2048 by 1536 pixels · fundus photo — 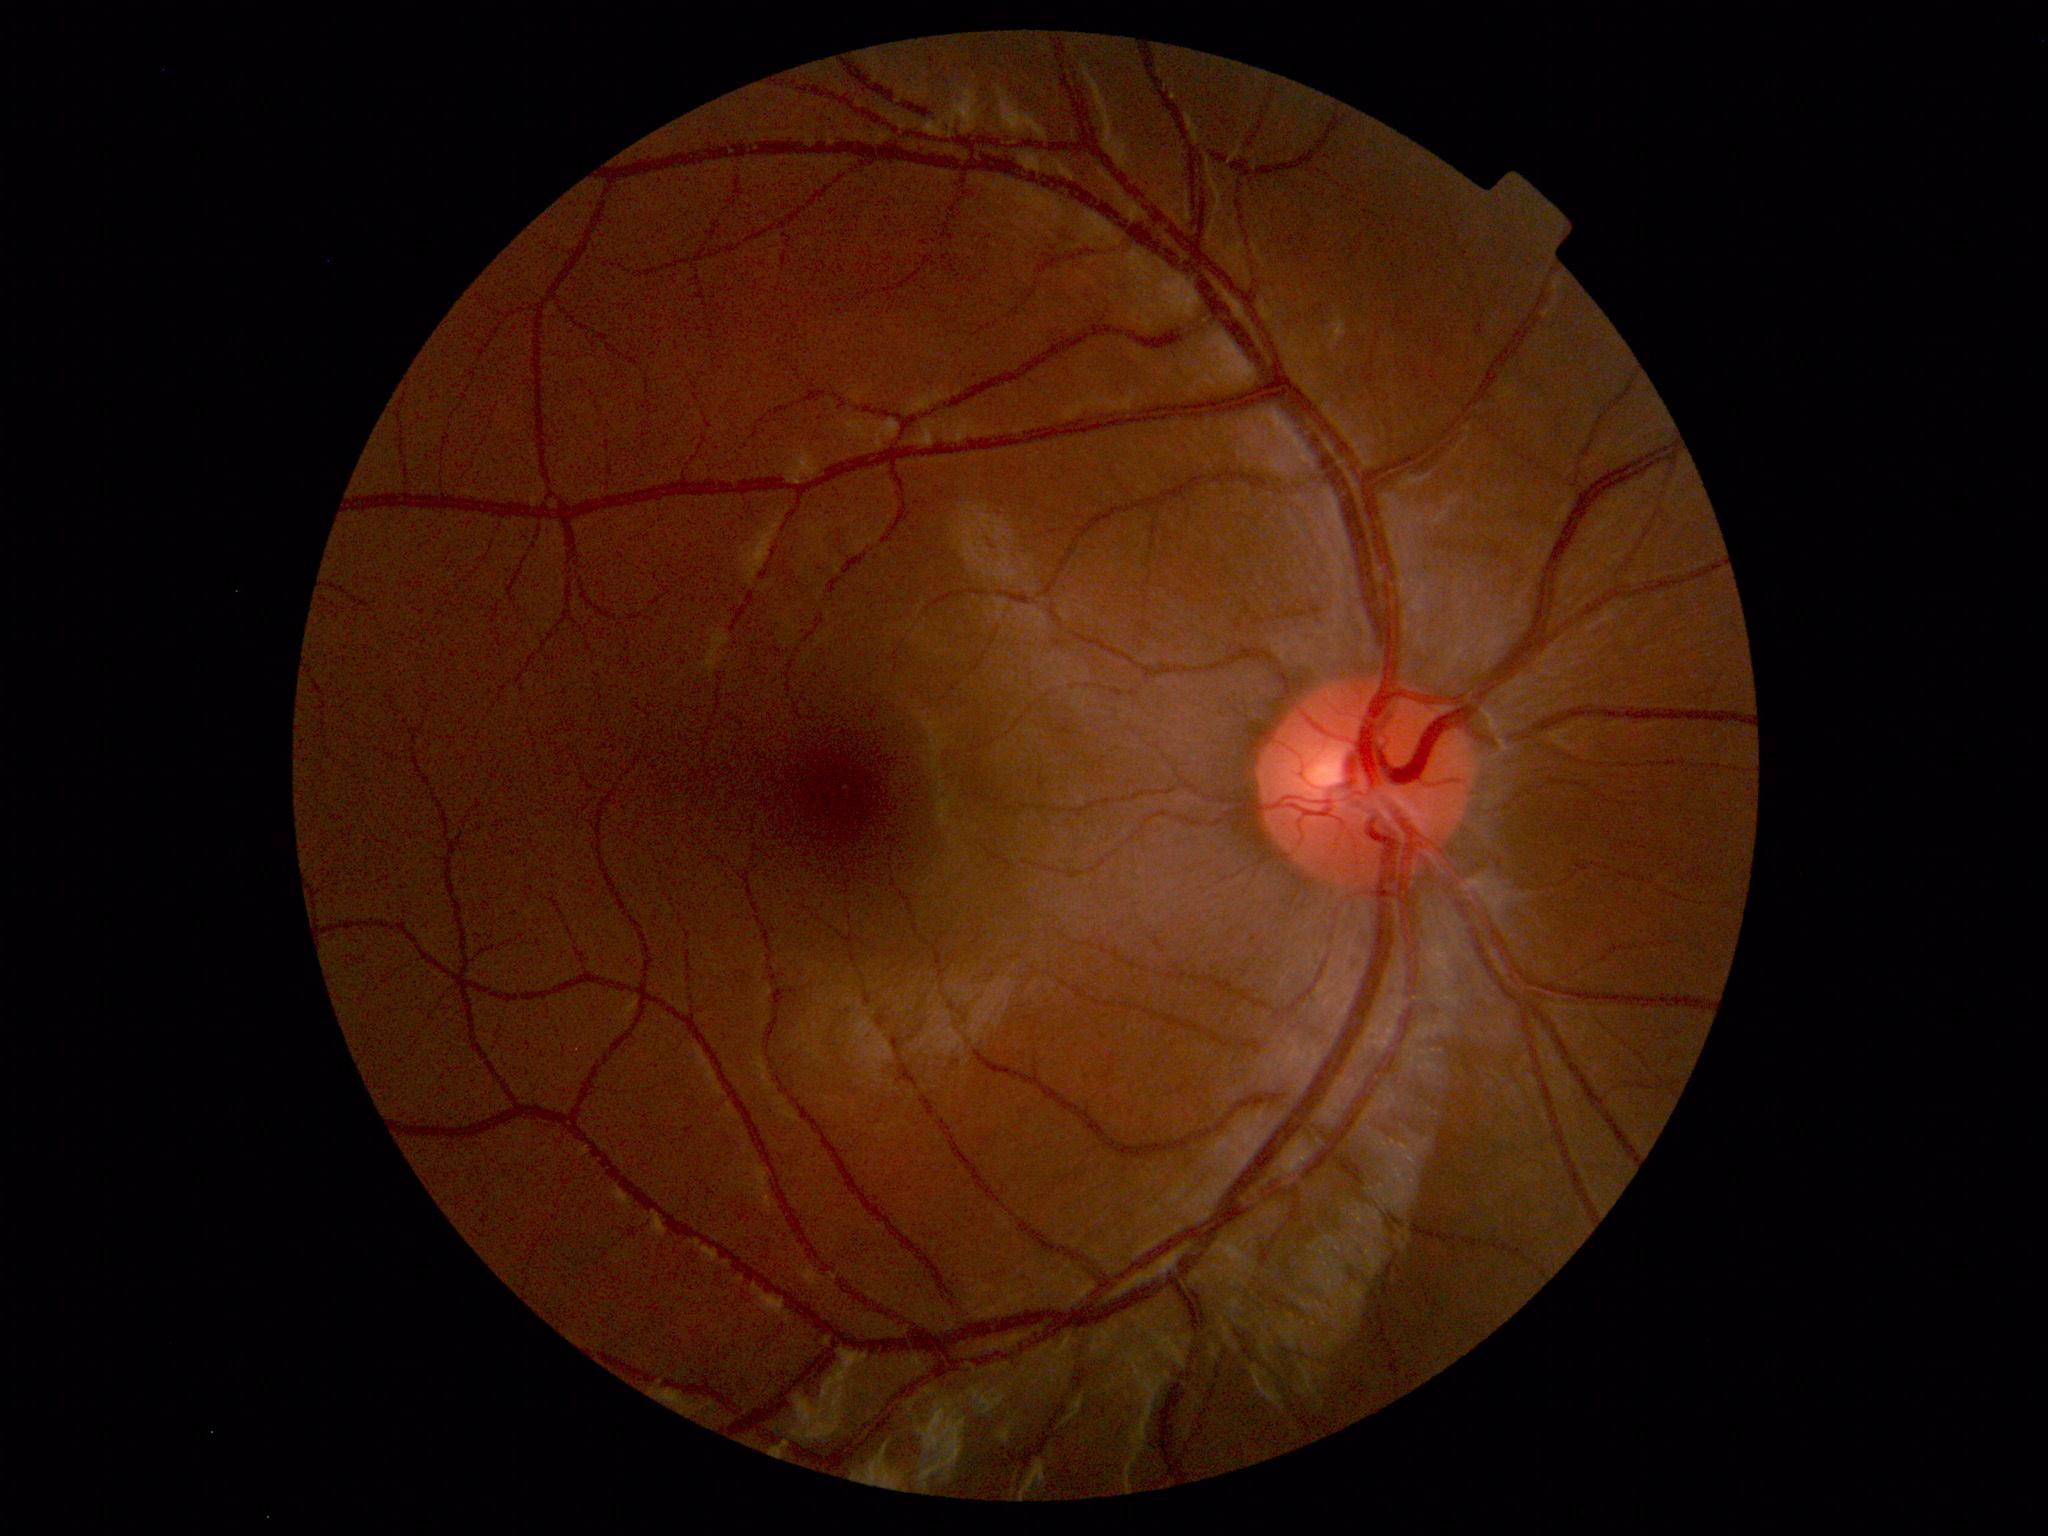

Impression: within normal limits.